FOV: 45 degrees; color fundus photograph
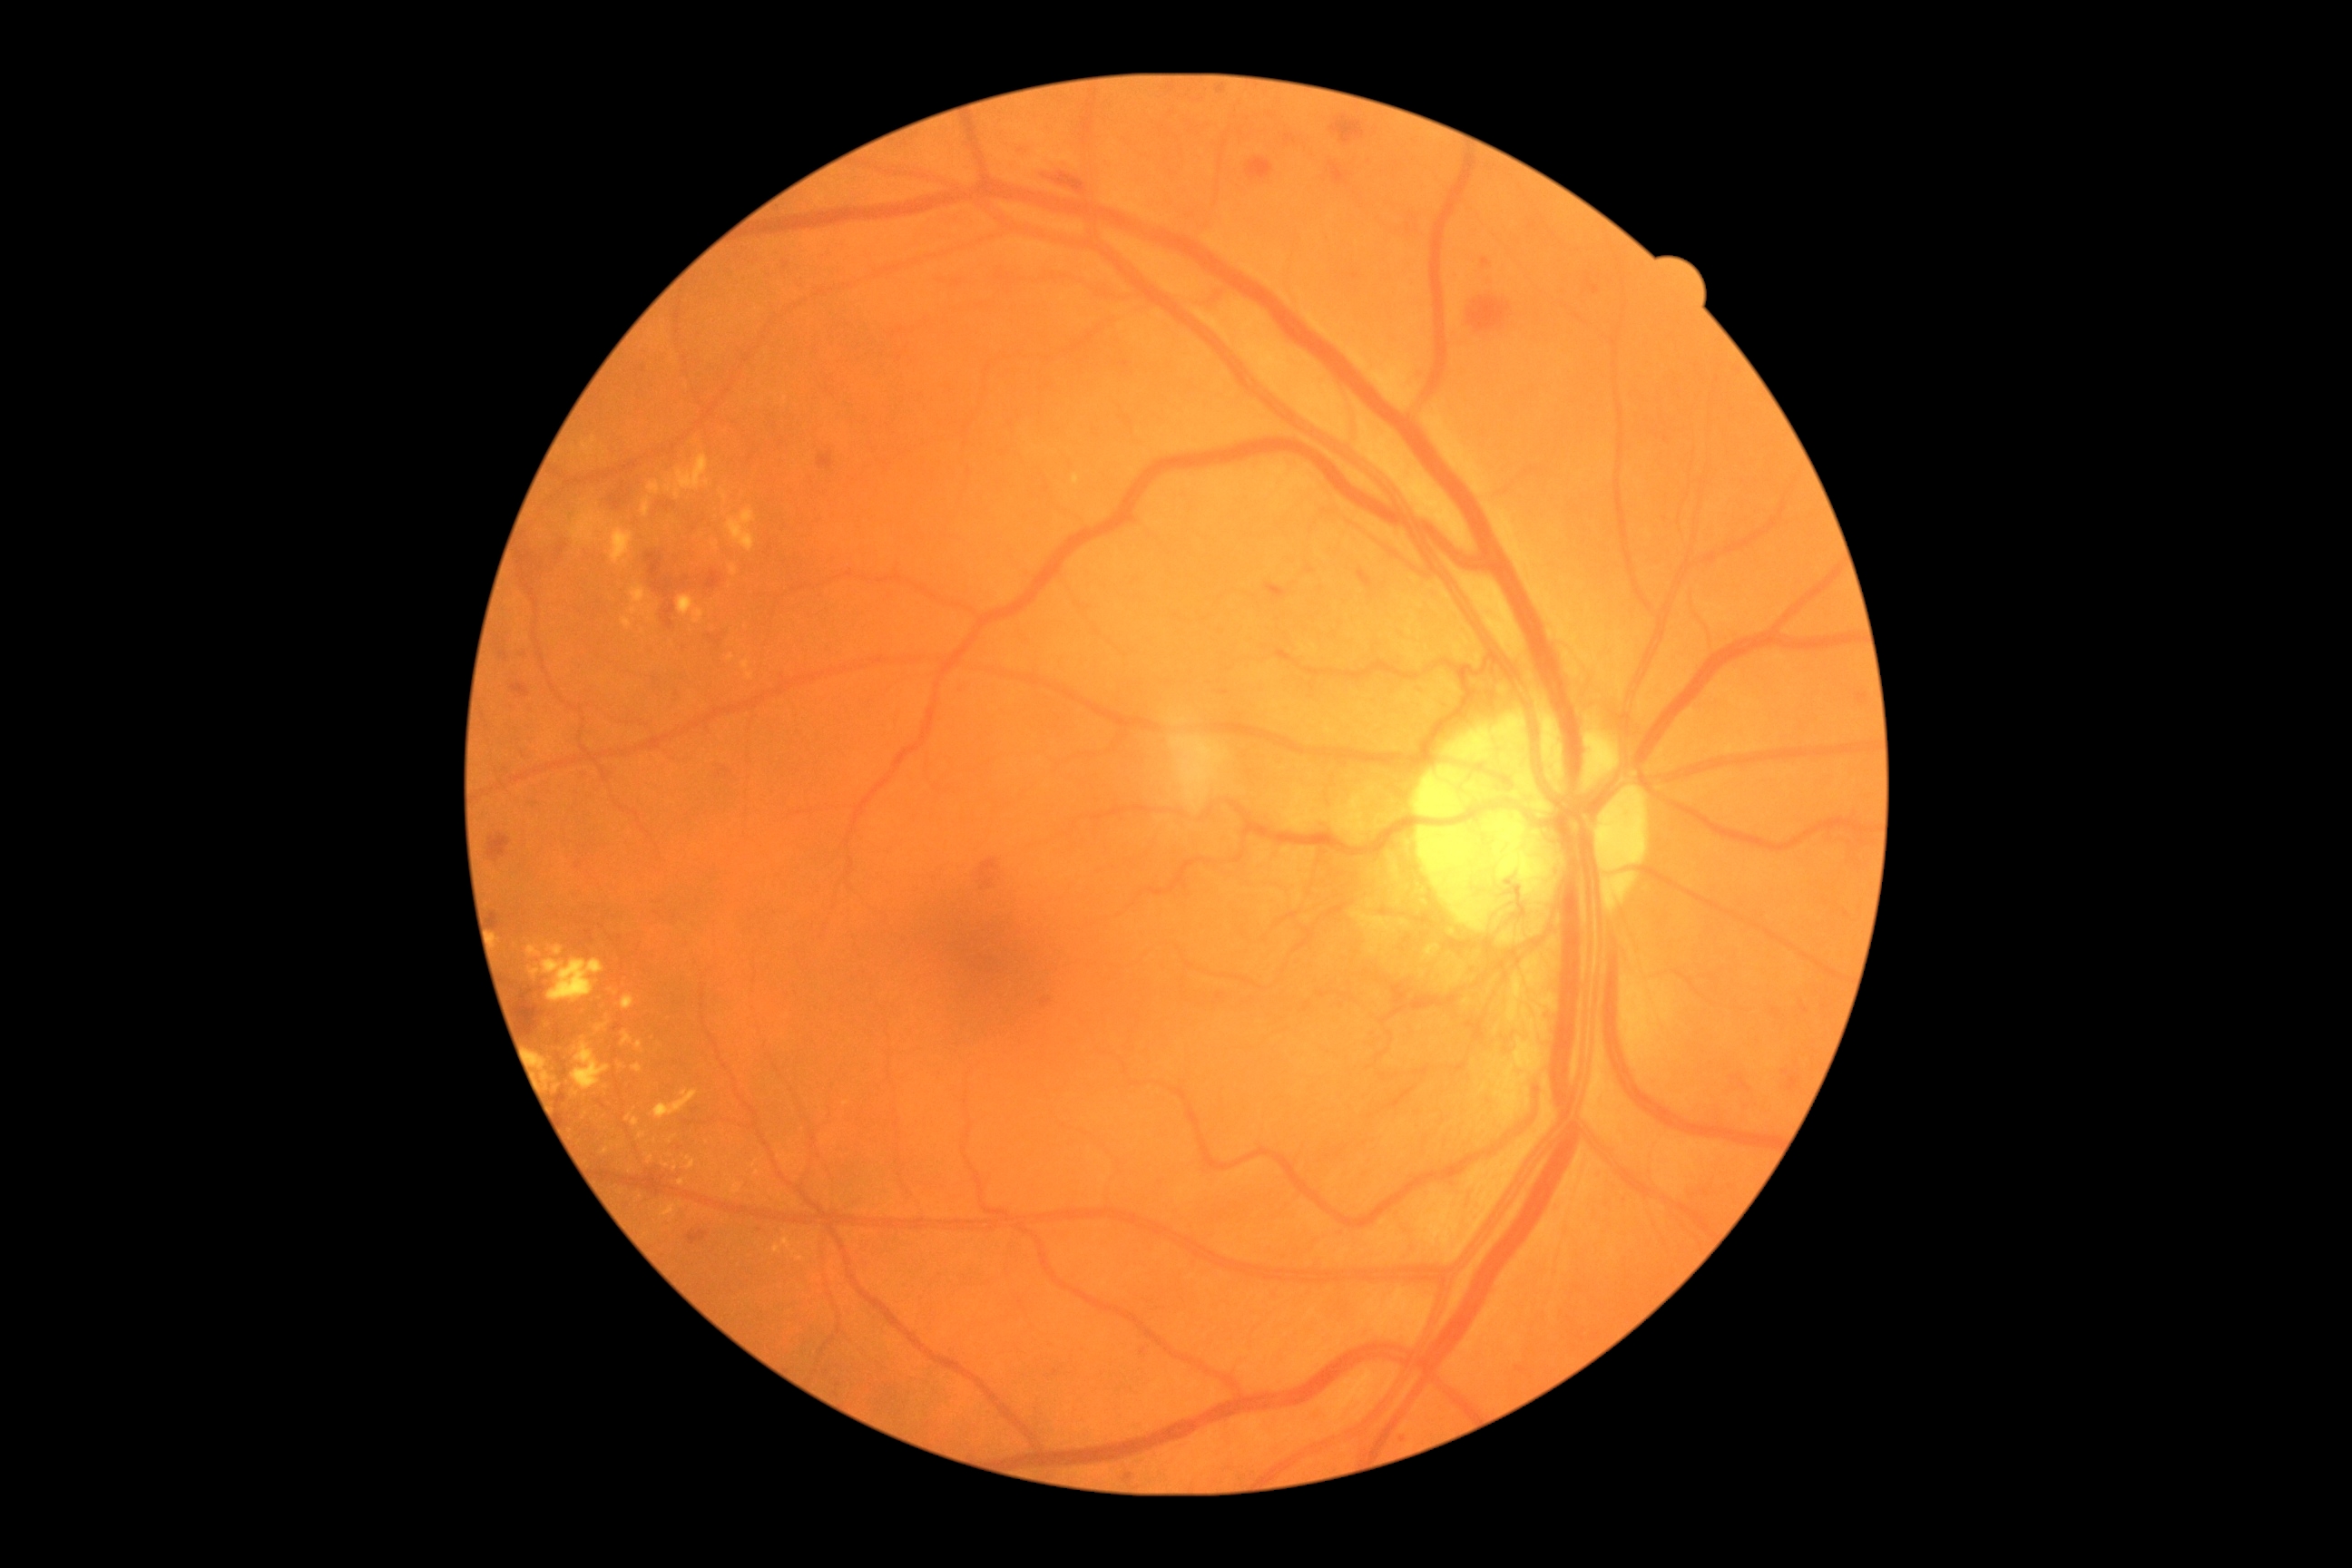 Diabetic retinopathy severity is grade 4 — neovascularization and/or vitreous/pre-retinal hemorrhage
Selected lesions:
hard exudates (partial) = [636, 1043, 645, 1054], [631, 607, 638, 616], [687, 1161, 696, 1170], [571, 1043, 612, 1090], [625, 1115, 640, 1126], [529, 946, 540, 957], [674, 489, 680, 498], [678, 596, 705, 623], [549, 945, 564, 957], [730, 567, 738, 576], [678, 455, 709, 491], [1073, 475, 1081, 485], [582, 438, 596, 456]
Small hard exudates near [621,1068], [681,1183], [715,546], [556,1089], [845,1103], [787,1162]
hemorrhages (partial) = [707, 634, 723, 645], [518, 988, 545, 1037], [1357, 571, 1373, 589], [1122, 362, 1130, 369], [687, 1231, 709, 1246], [487, 834, 511, 863], [662, 603, 676, 629], [1246, 159, 1273, 181], [1331, 115, 1366, 144], [1266, 583, 1288, 600]